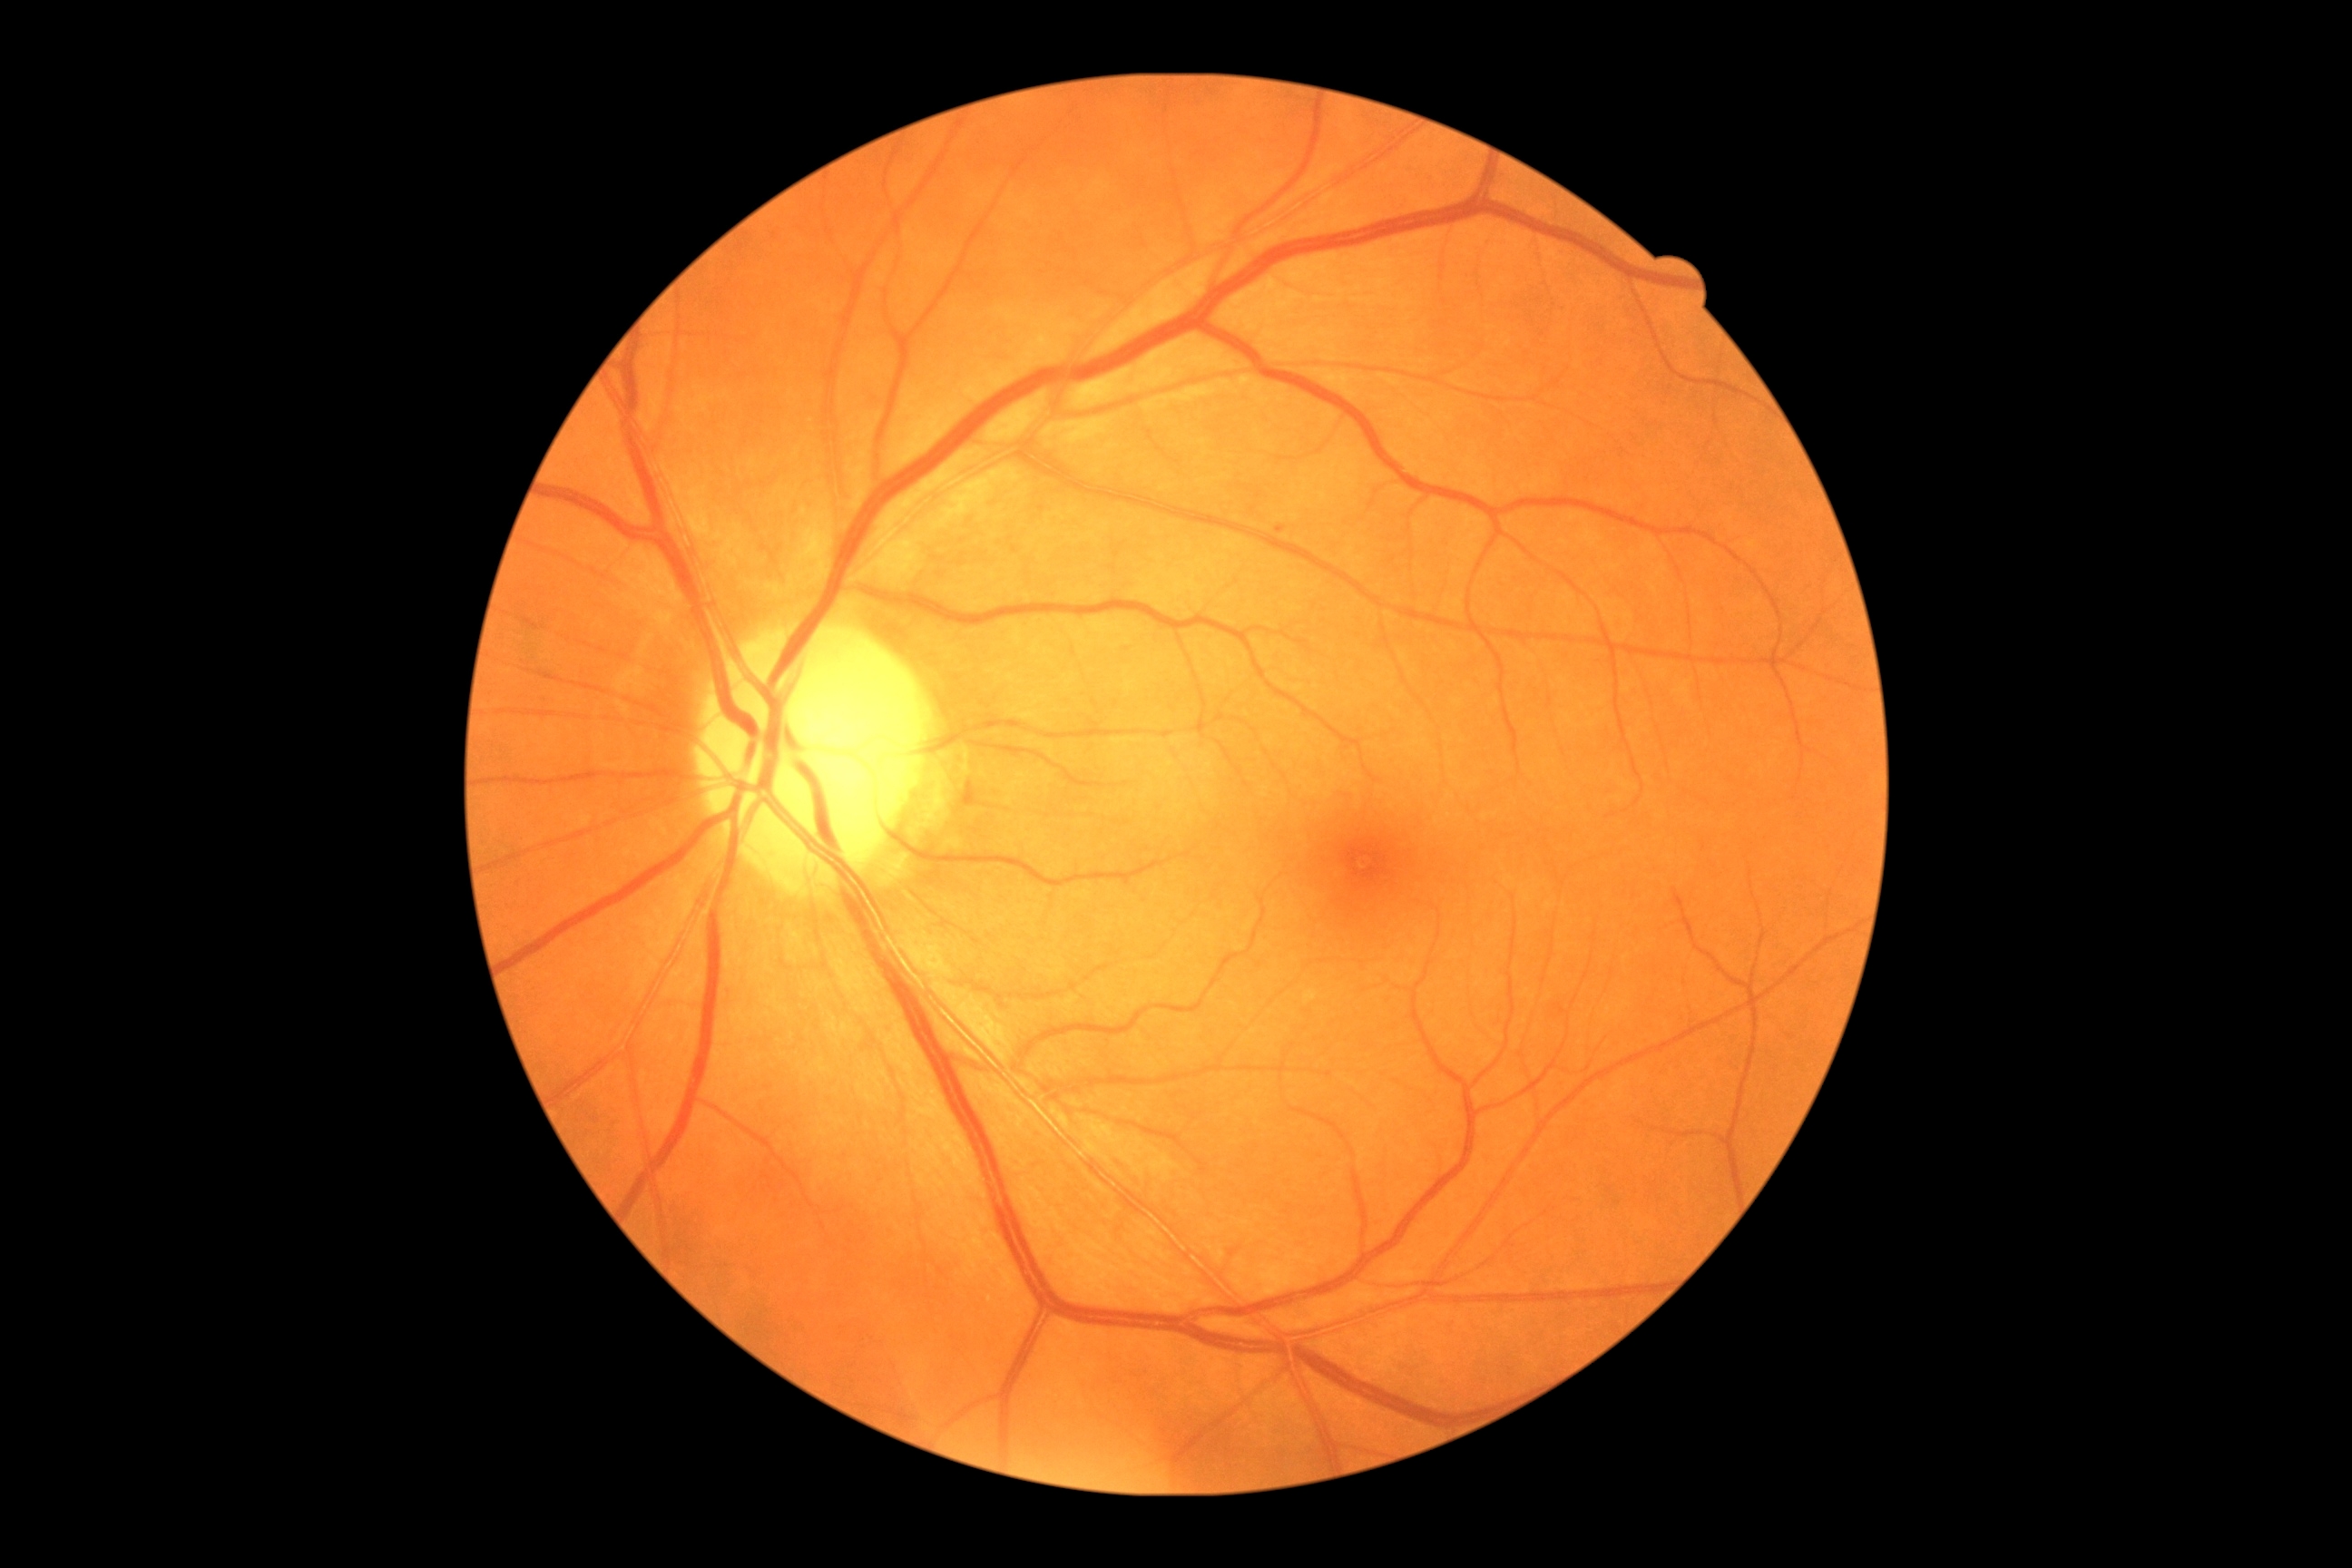 DR grade = mild non-proliferative diabetic retinopathy (1) — presence of microaneurysms only, DR class = non-proliferative diabetic retinopathy.